Phoenix ICON, 100° FOV; 1240x1240; wide-field fundus image from infant ROP screening — 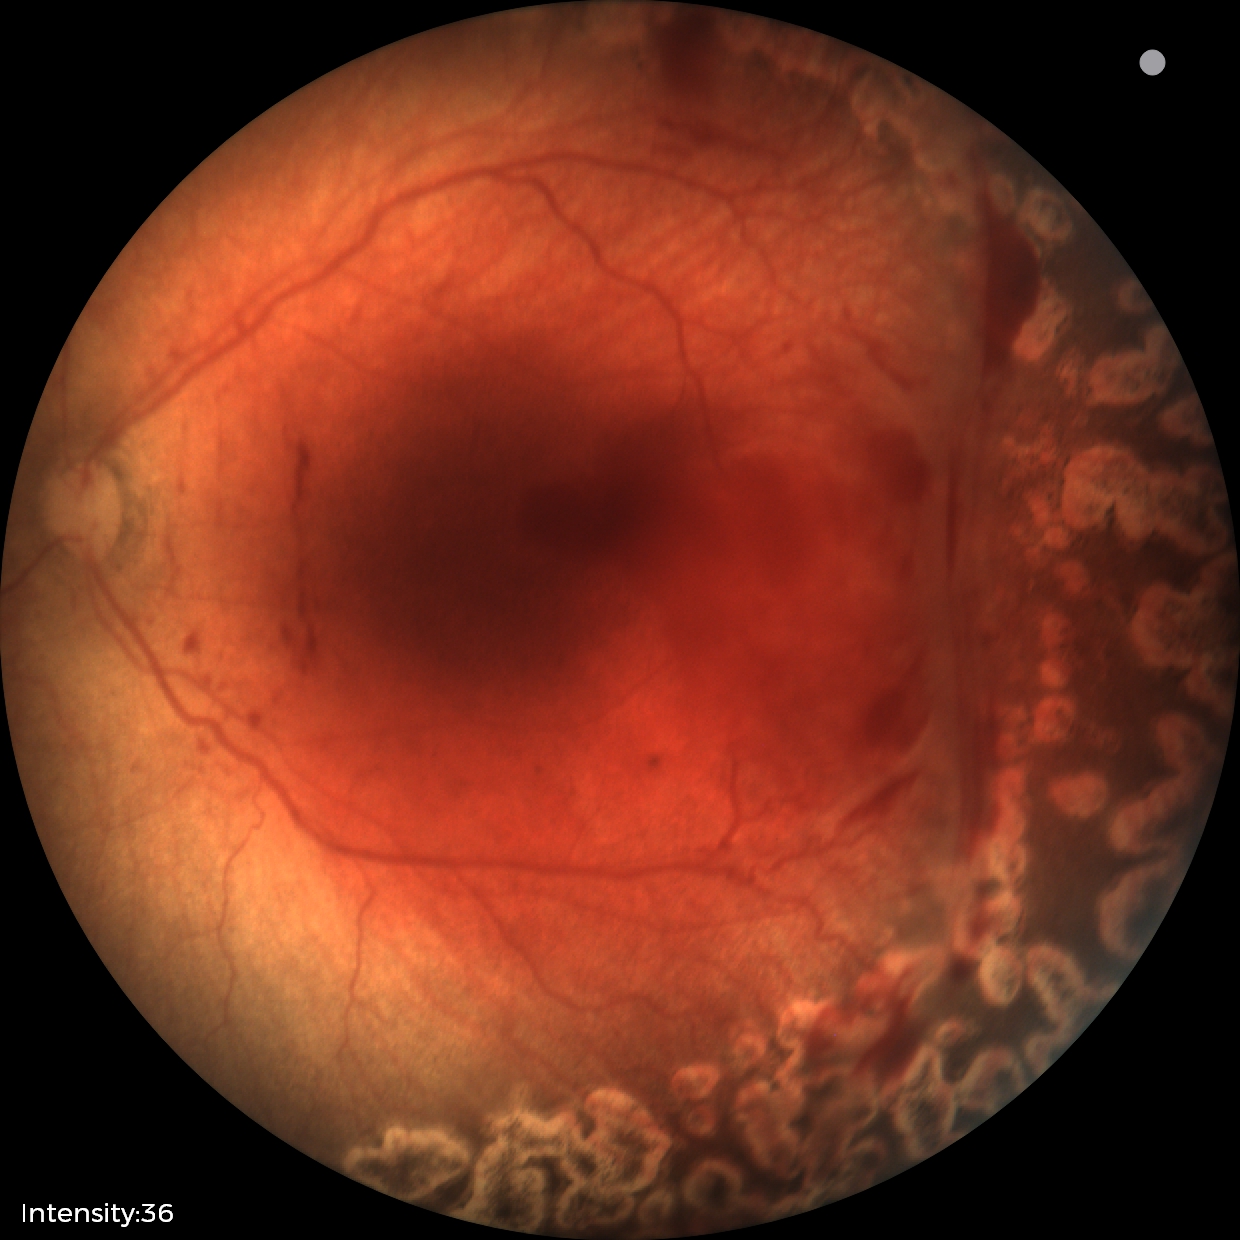
Impression: status post retinopathy of prematurity; no plus disease — posterior pole vessels without abnormal dilation or tortuosity.